Retinal fundus photograph; no pharmacologic dilation; 848 x 848 pixels: 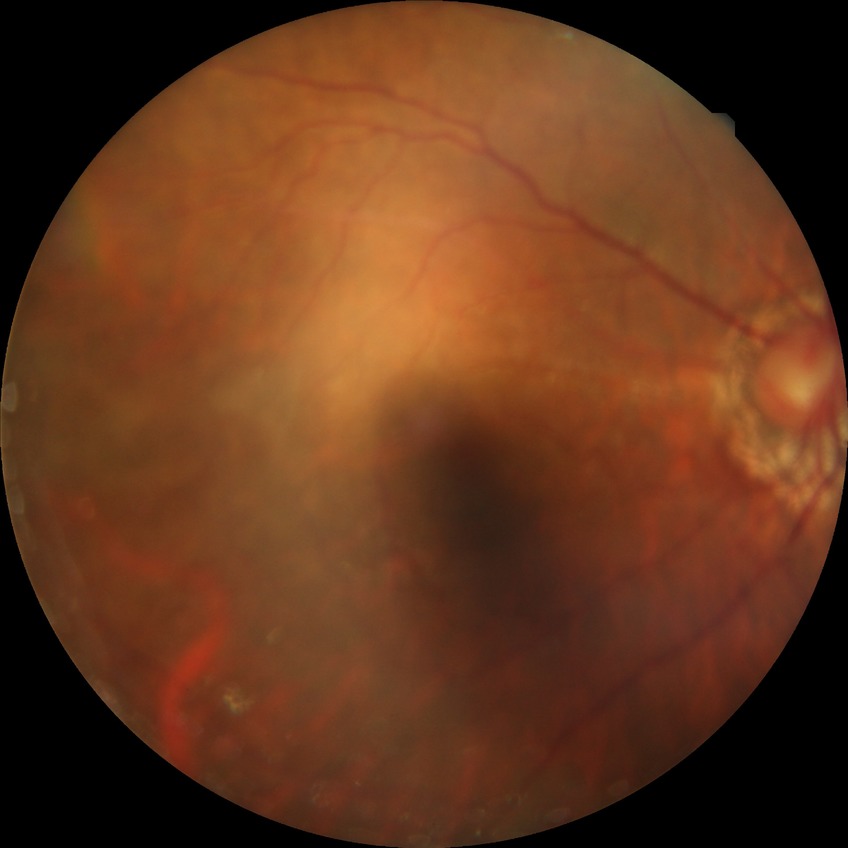
Davis grade@NDR.